Topcon TRC fundus camera · fundus photograph cropped around the optic nerve head — 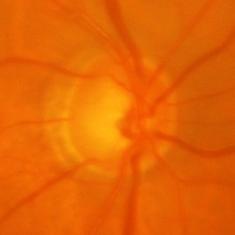

Glaucomatous changes are present. Diagnosis = glaucomatous findings.